No pharmacologic dilation · NIDEK AFC-230 · DR severity per modified Davis staging · posterior pole color fundus photograph · 848 by 848 pixels — 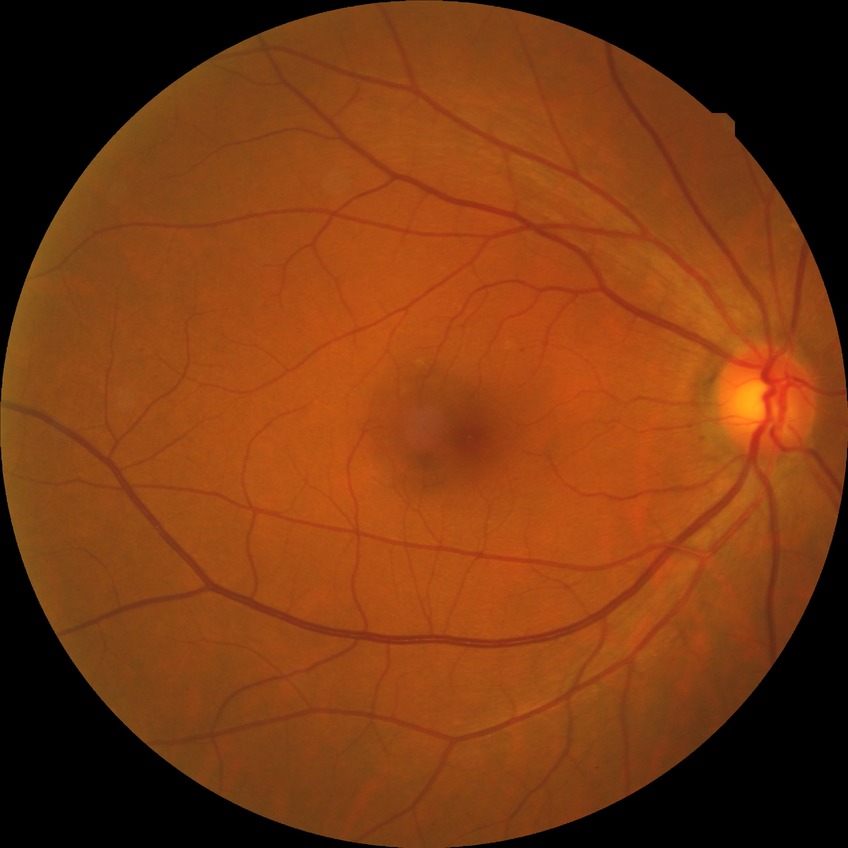

{
  "davis_grade": "NDR"
}